Remidio Fundus on Phone (FOP) camera. 1659 by 2212 pixels.
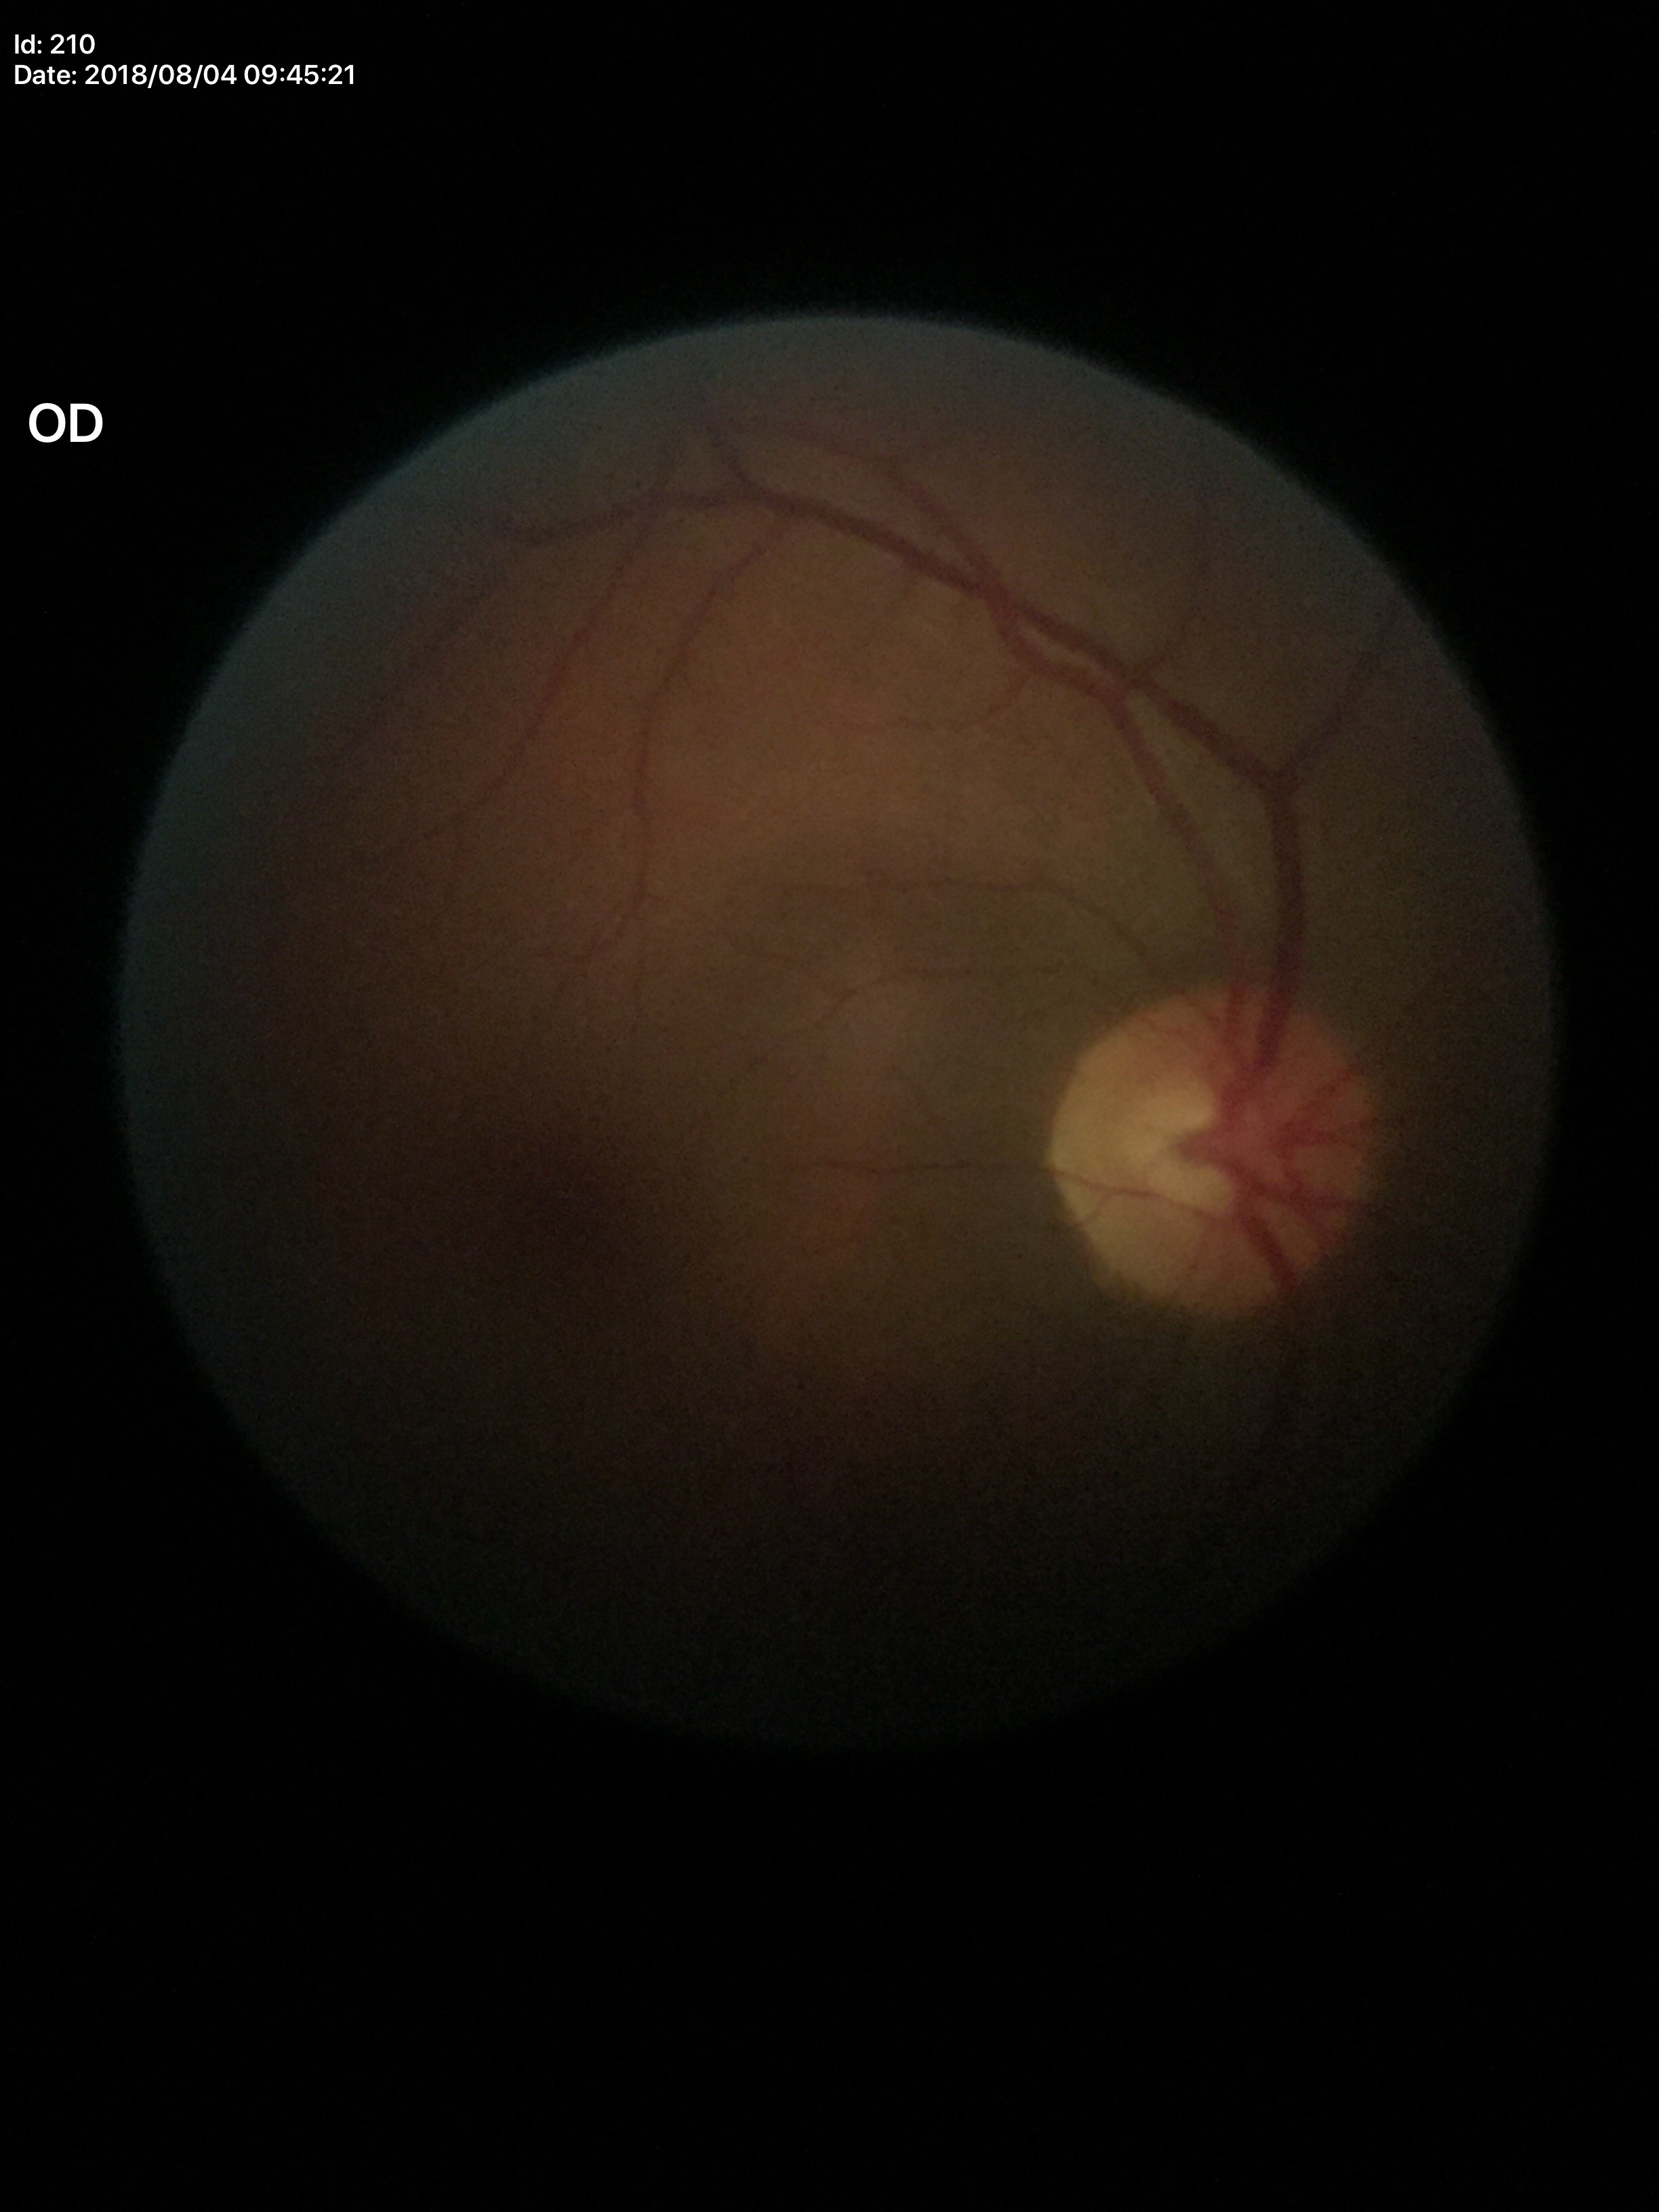 No glaucomatous findings (all 5 graders called normal).
VCDR is 0.54.